2212x1659
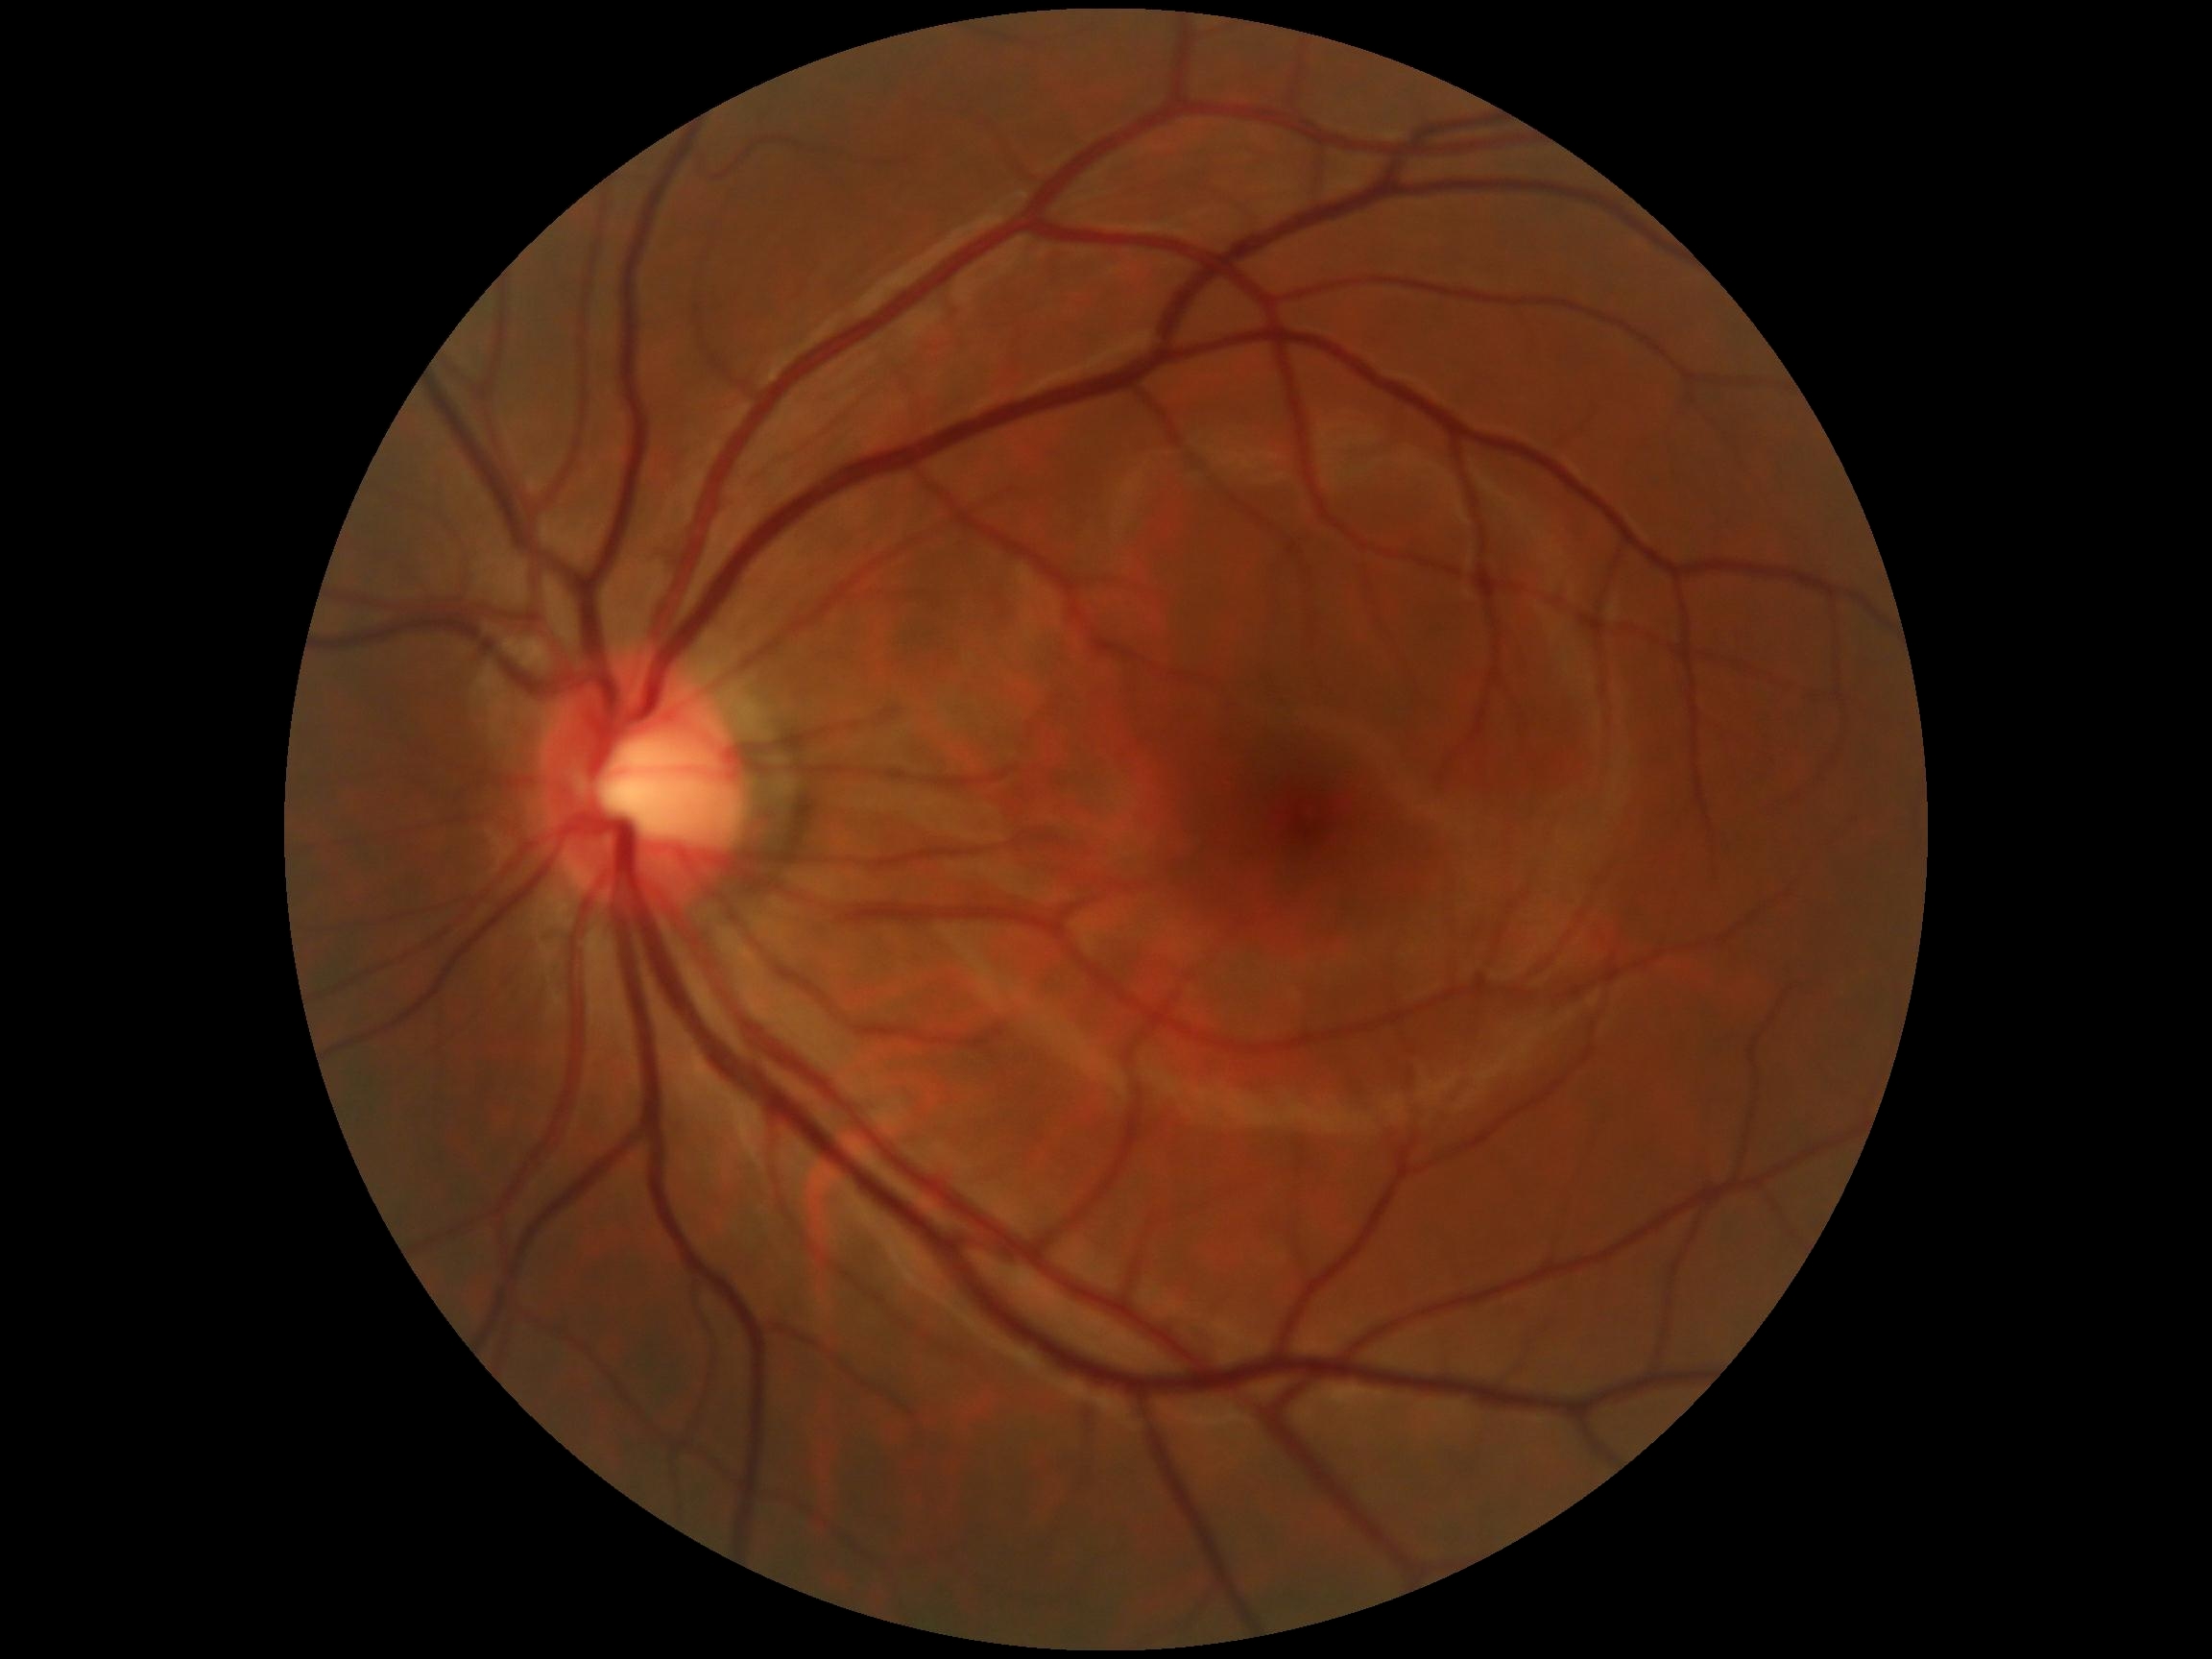
Diabetic retinopathy grade is no apparent diabetic retinopathy (0). No apparent diabetic retinopathy.